45° field of view:
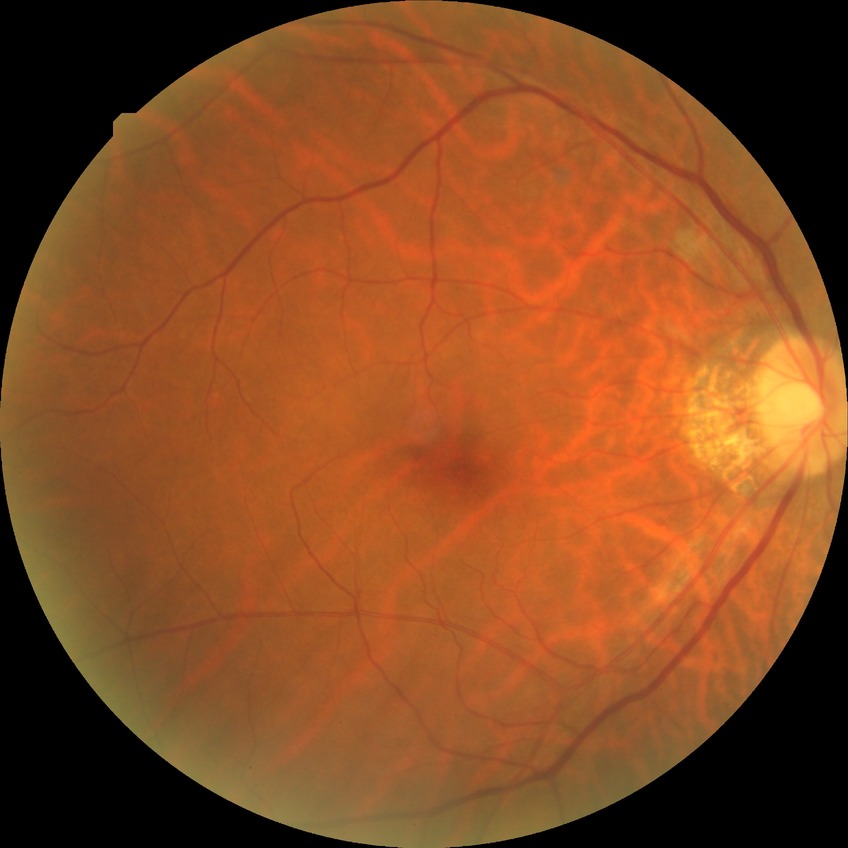
Diabetic retinopathy (DR): no diabetic retinopathy (NDR).